NIDEK AFC-230 fundus camera. Retinal fundus photograph. Graded on the modified Davis scale:
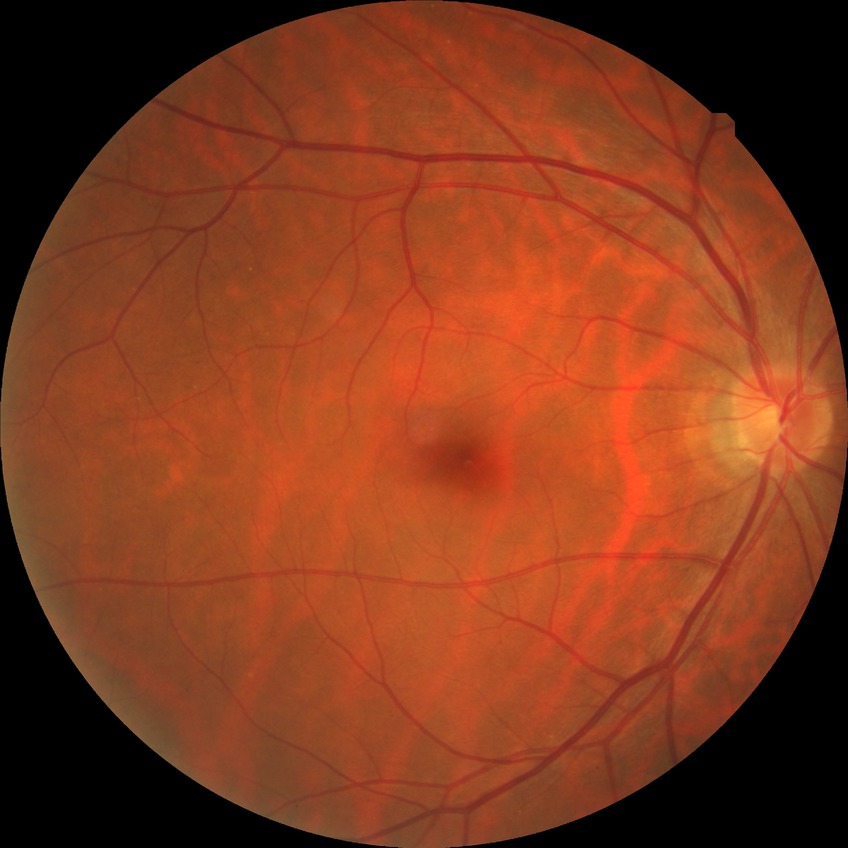 Diabetic retinopathy (DR) is no diabetic retinopathy (NDR).